45 degree fundus photograph, Davis DR grading:
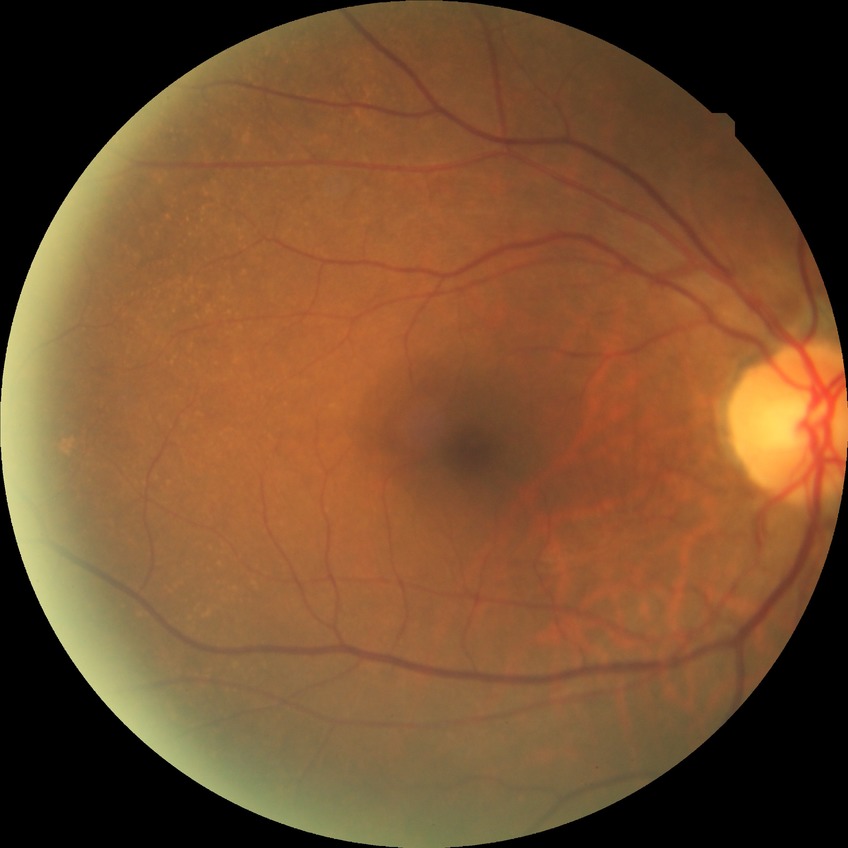
diabetic retinopathy stage: no diabetic retinopathy.